Optic nerve head photograph · 1096x1096px · FOV 35° before cropping
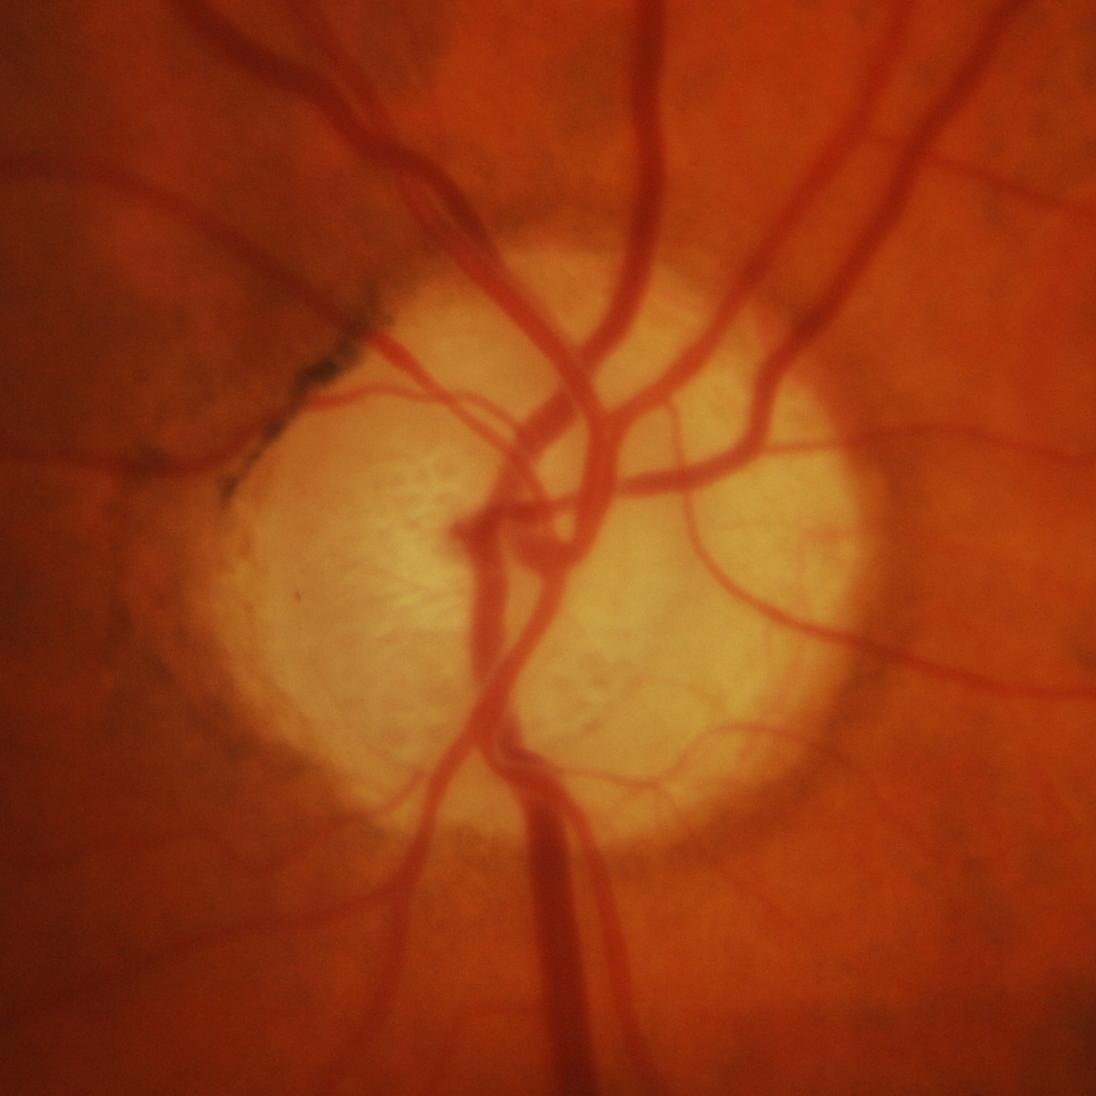 Q: What is the glaucoma diagnosis?
A: Yes — glaucomatous damage to the optic nerve.